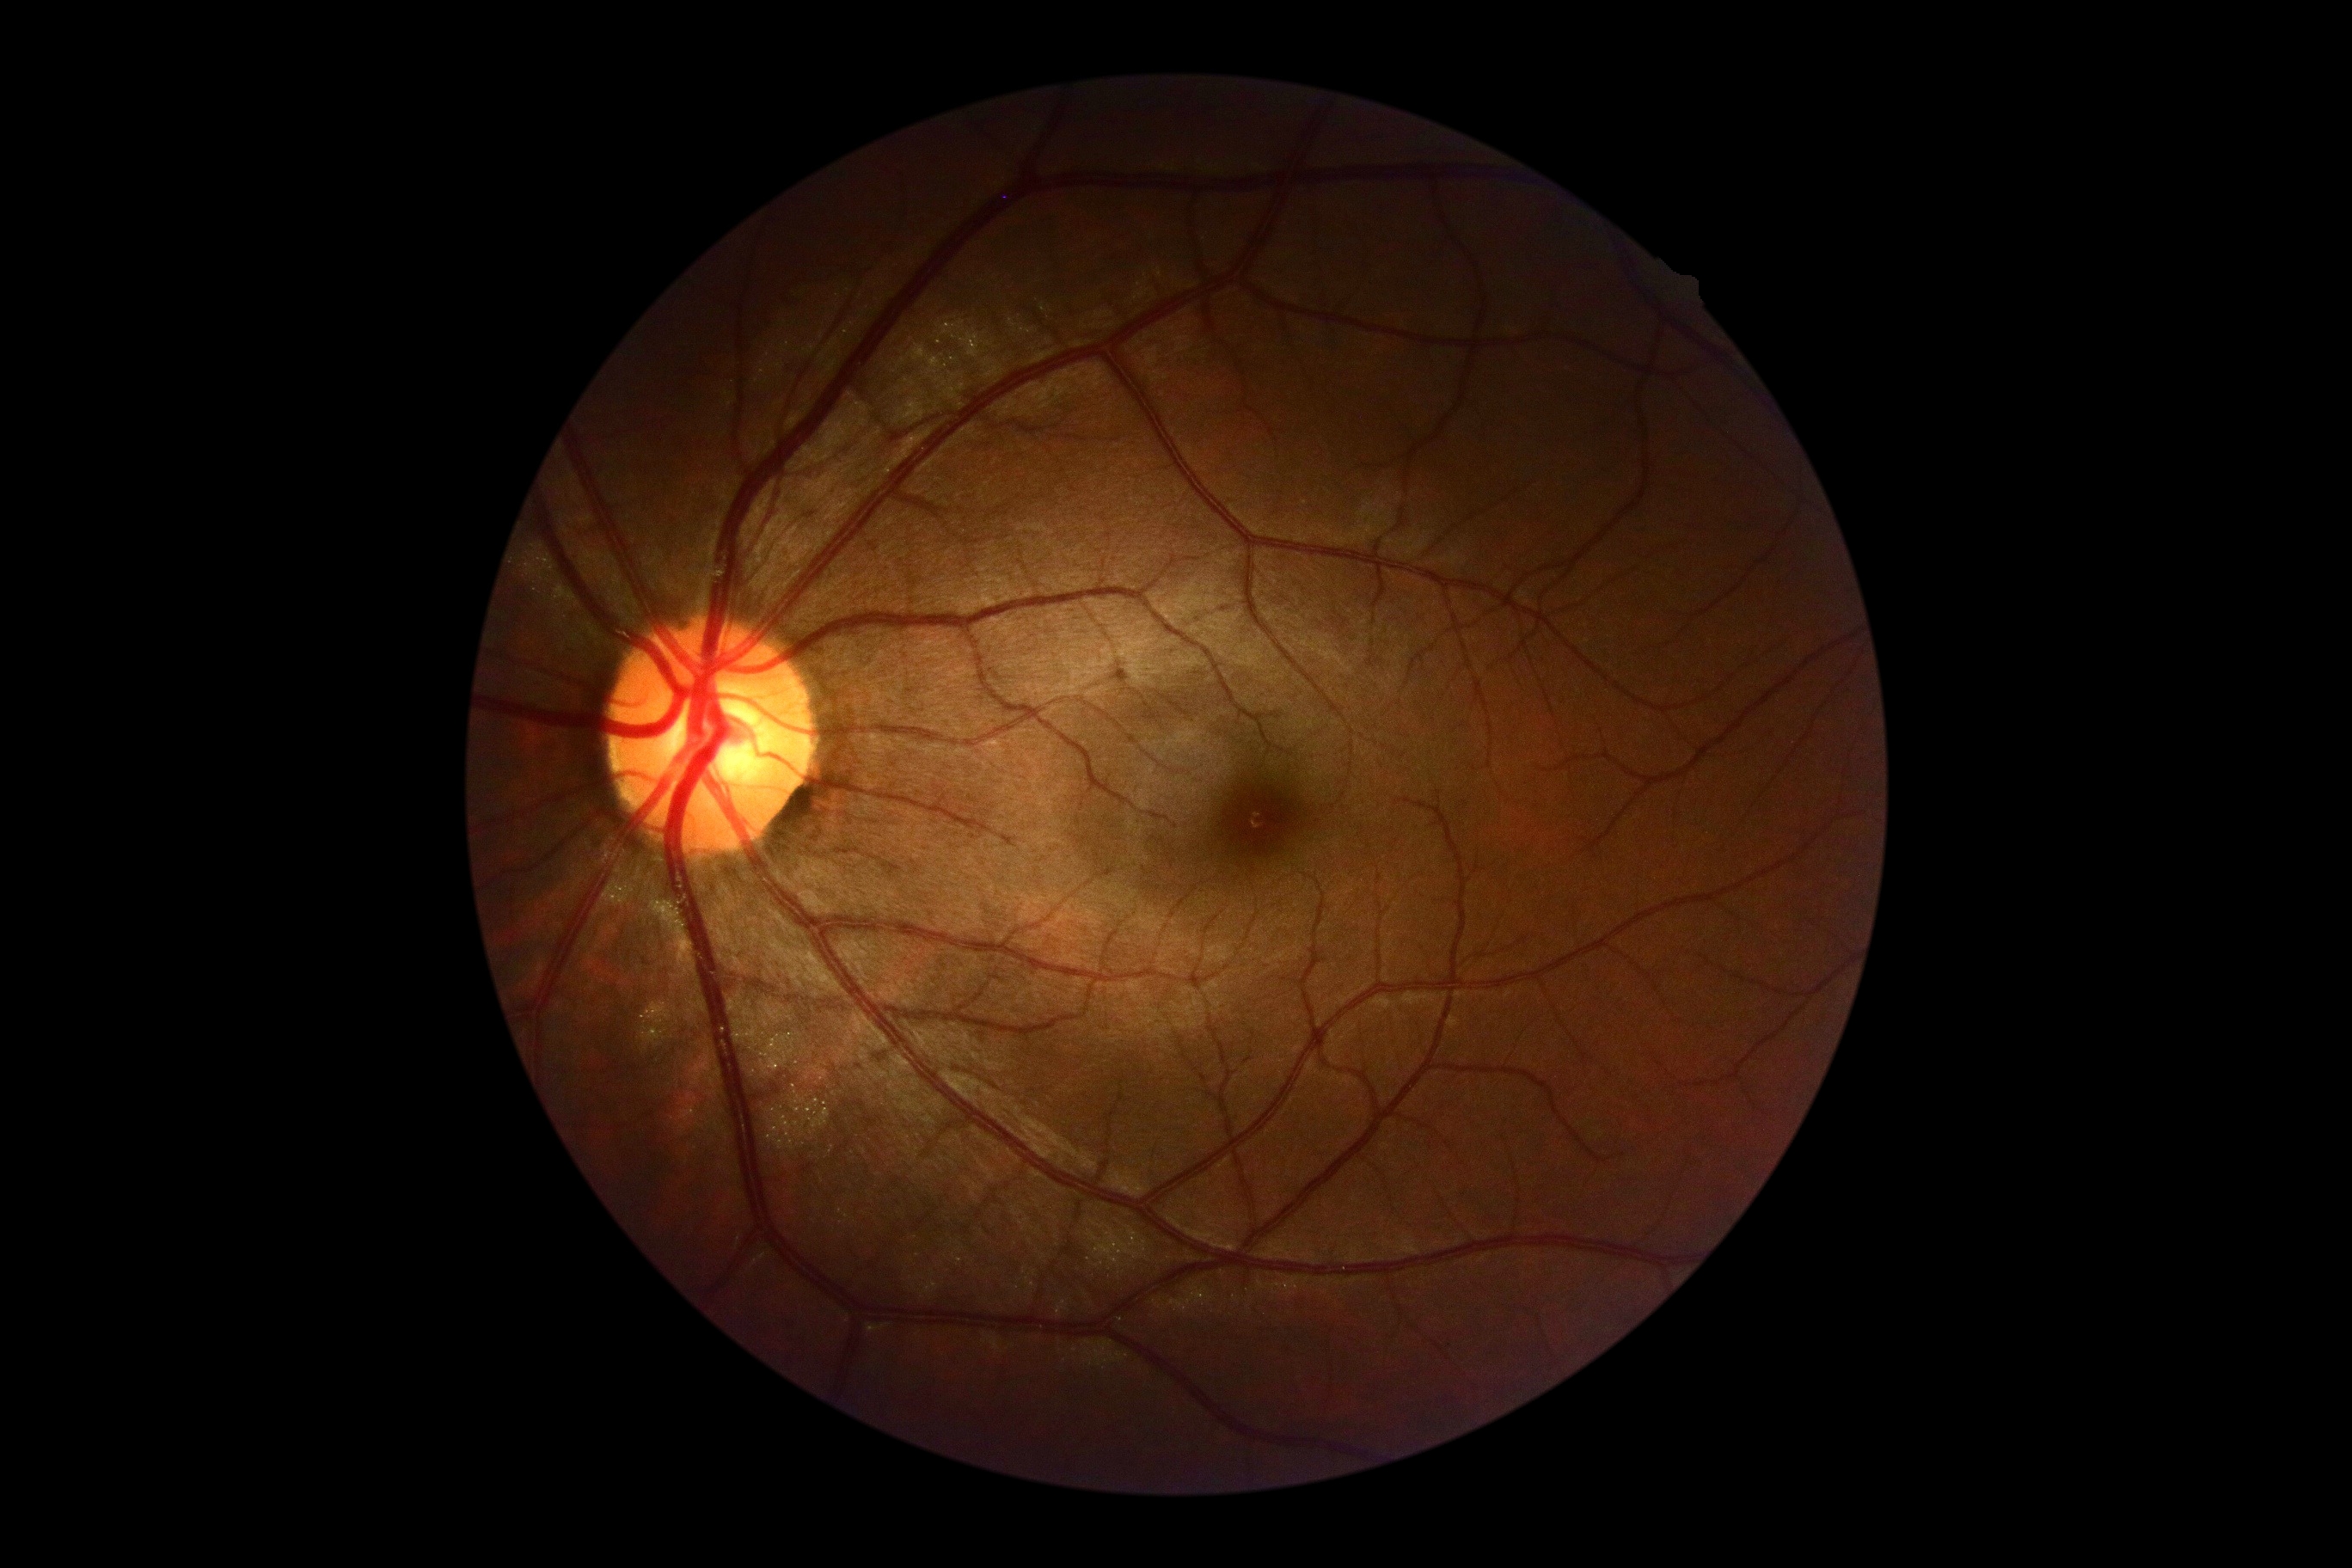 DR is 0.